Wide-field fundus image from infant ROP screening. Captured with the Phoenix ICON (100° field of view).
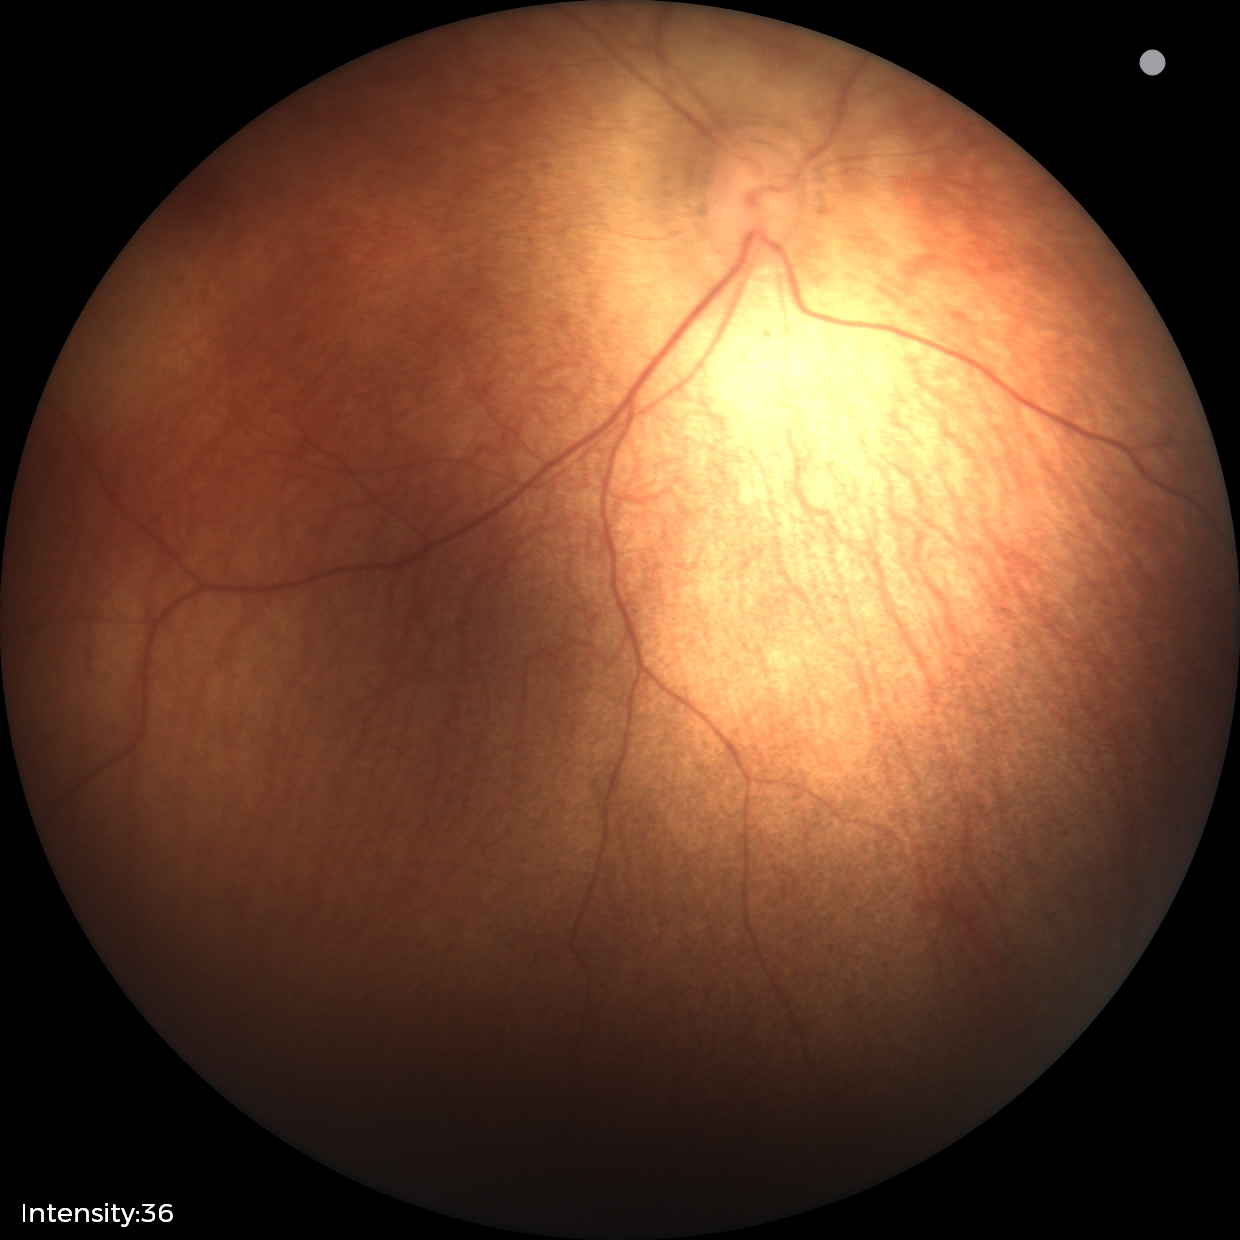
Normal screening examination.